1920x1440px. Color fundus photograph
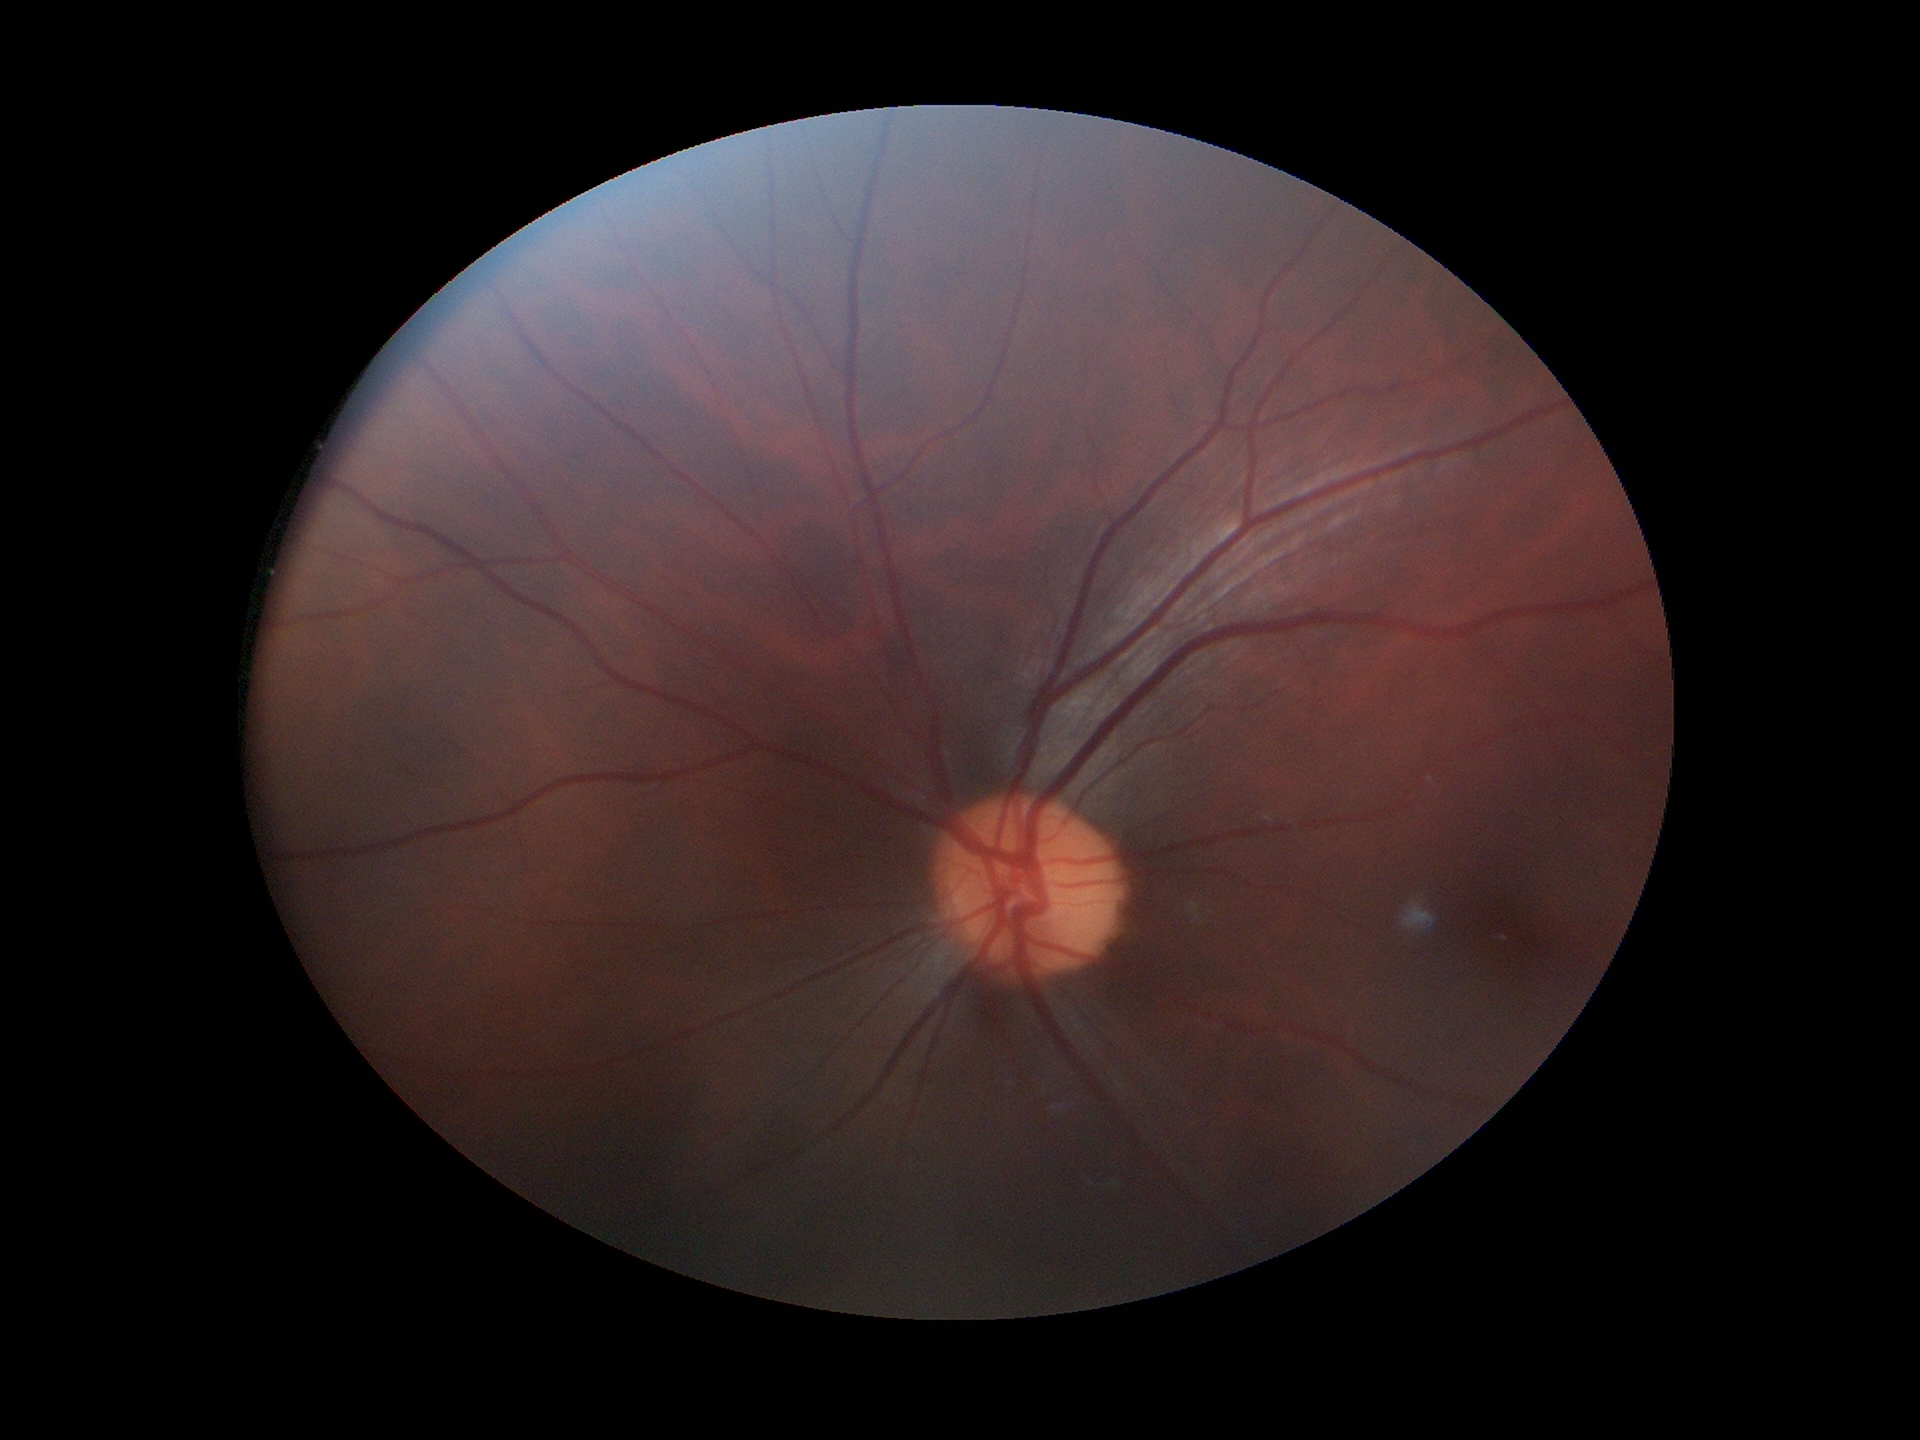
Glaucoma assessment: negative. Vertical cup-to-disc ratio is 0.47.